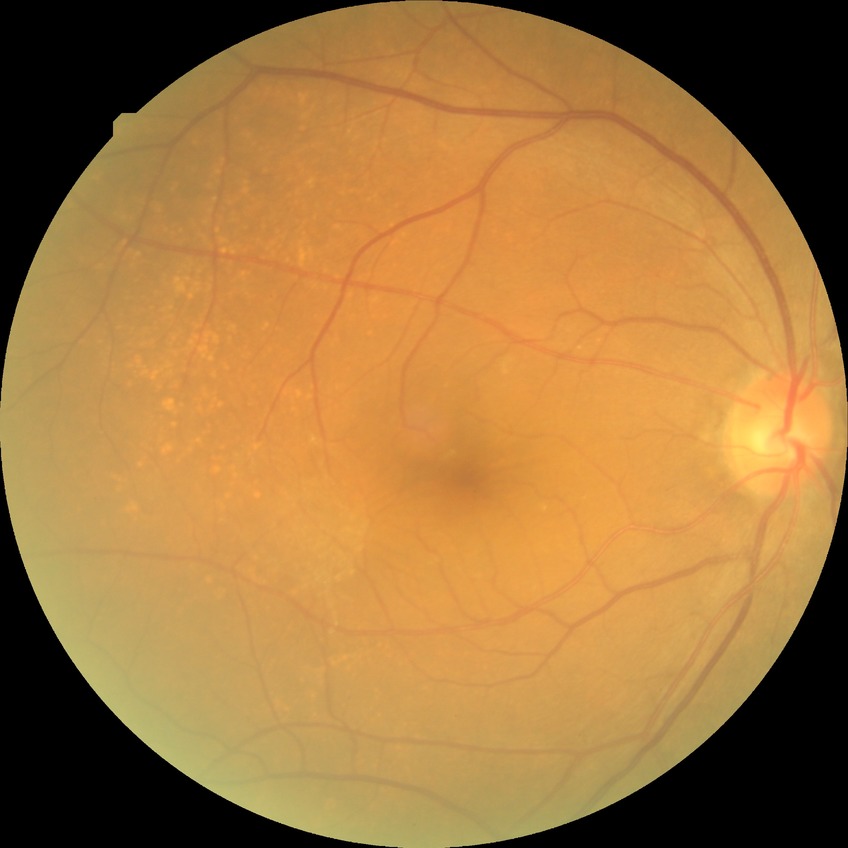

Modified Davis grading is no diabetic retinopathy.